Infant wide-field retinal image:
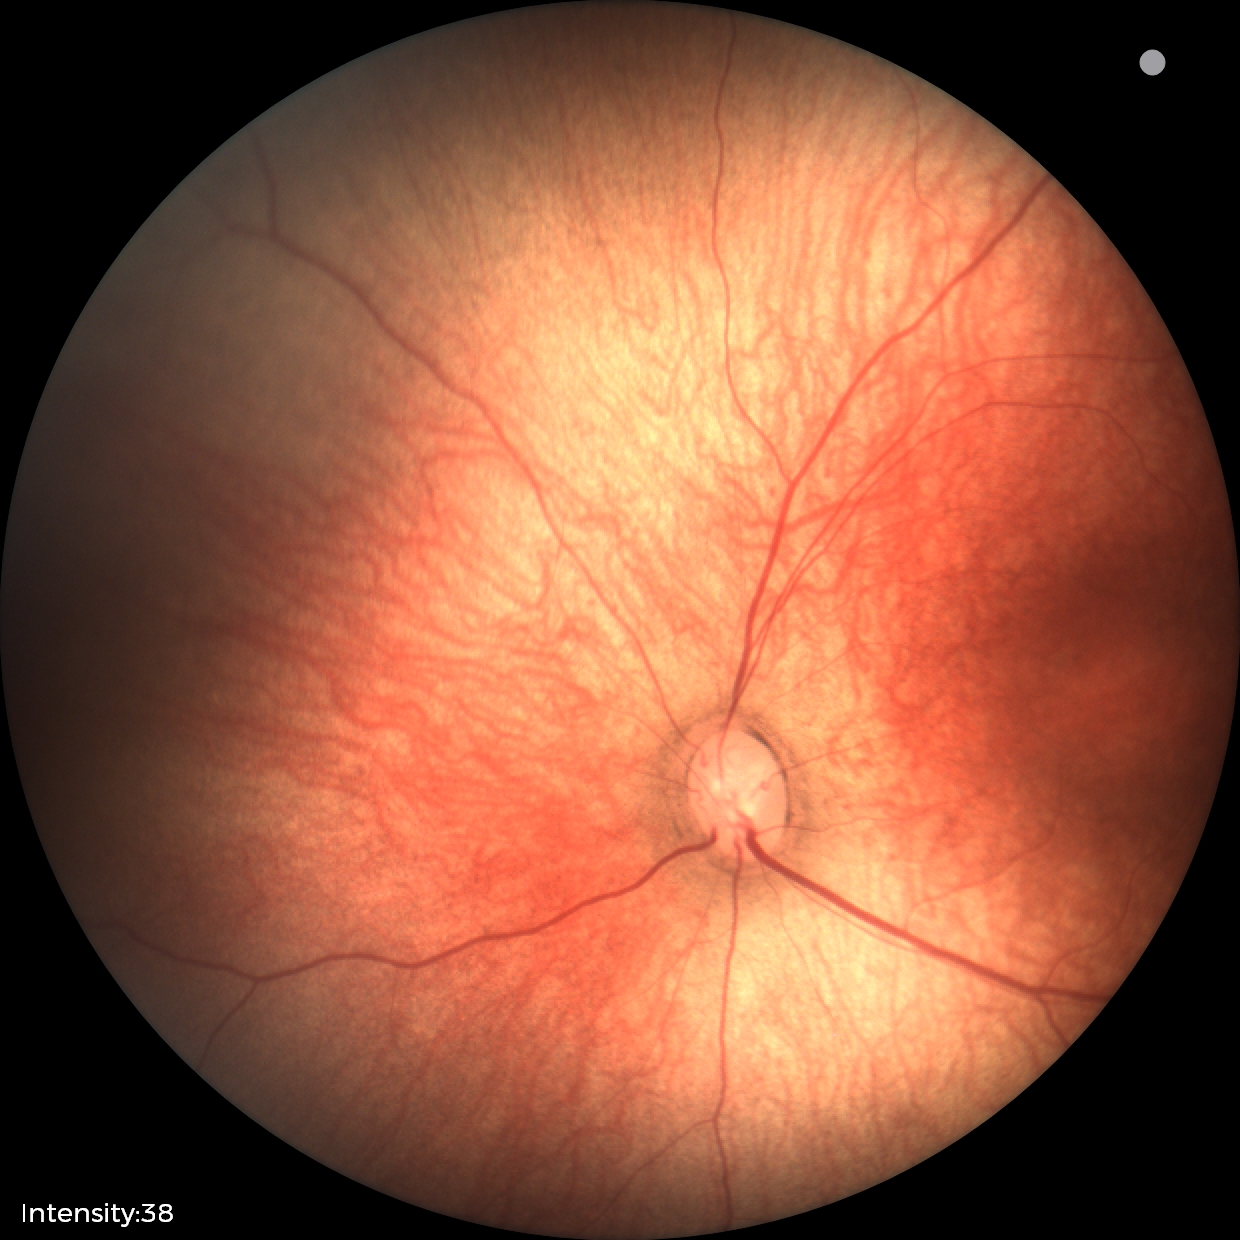

Physiological retinal appearance for postconceptual age.